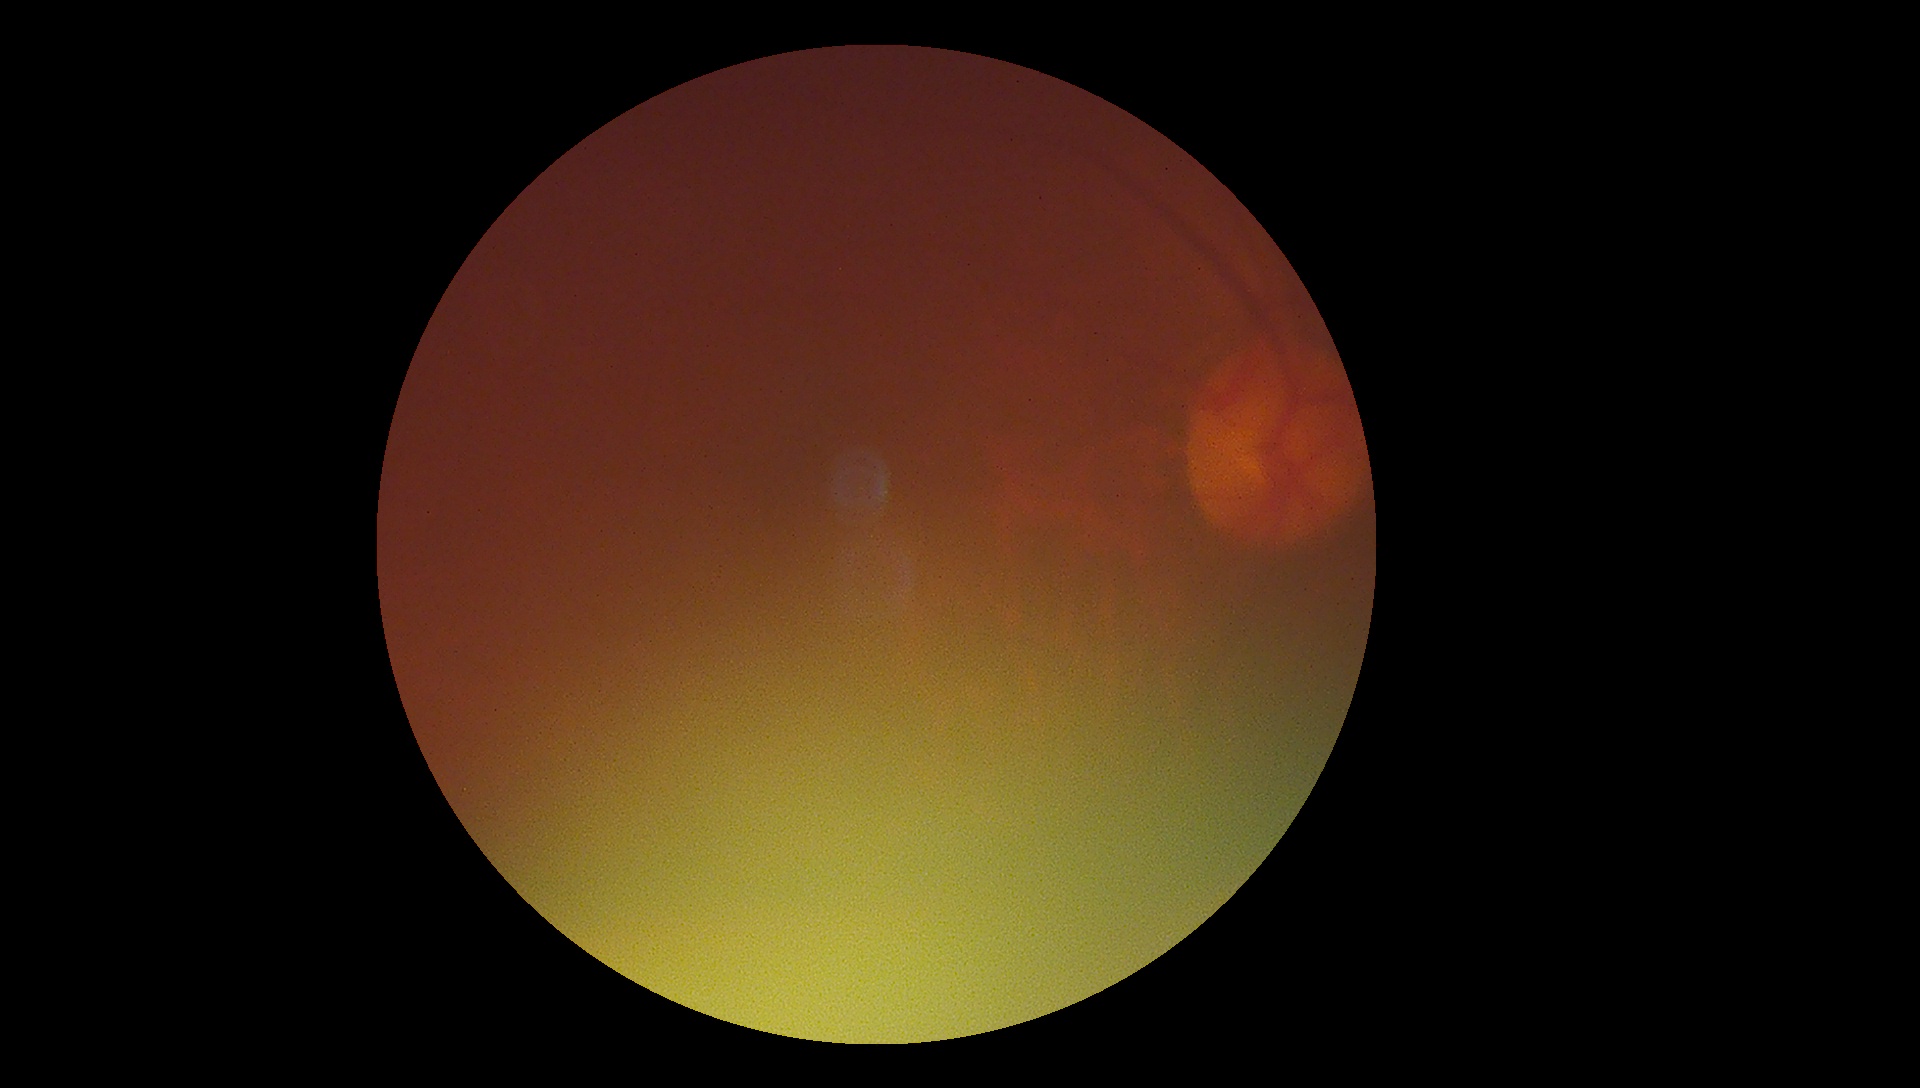
Quality too poor to assess for DR.
DR is ungradable due to poor image quality.